45-degree field of view — 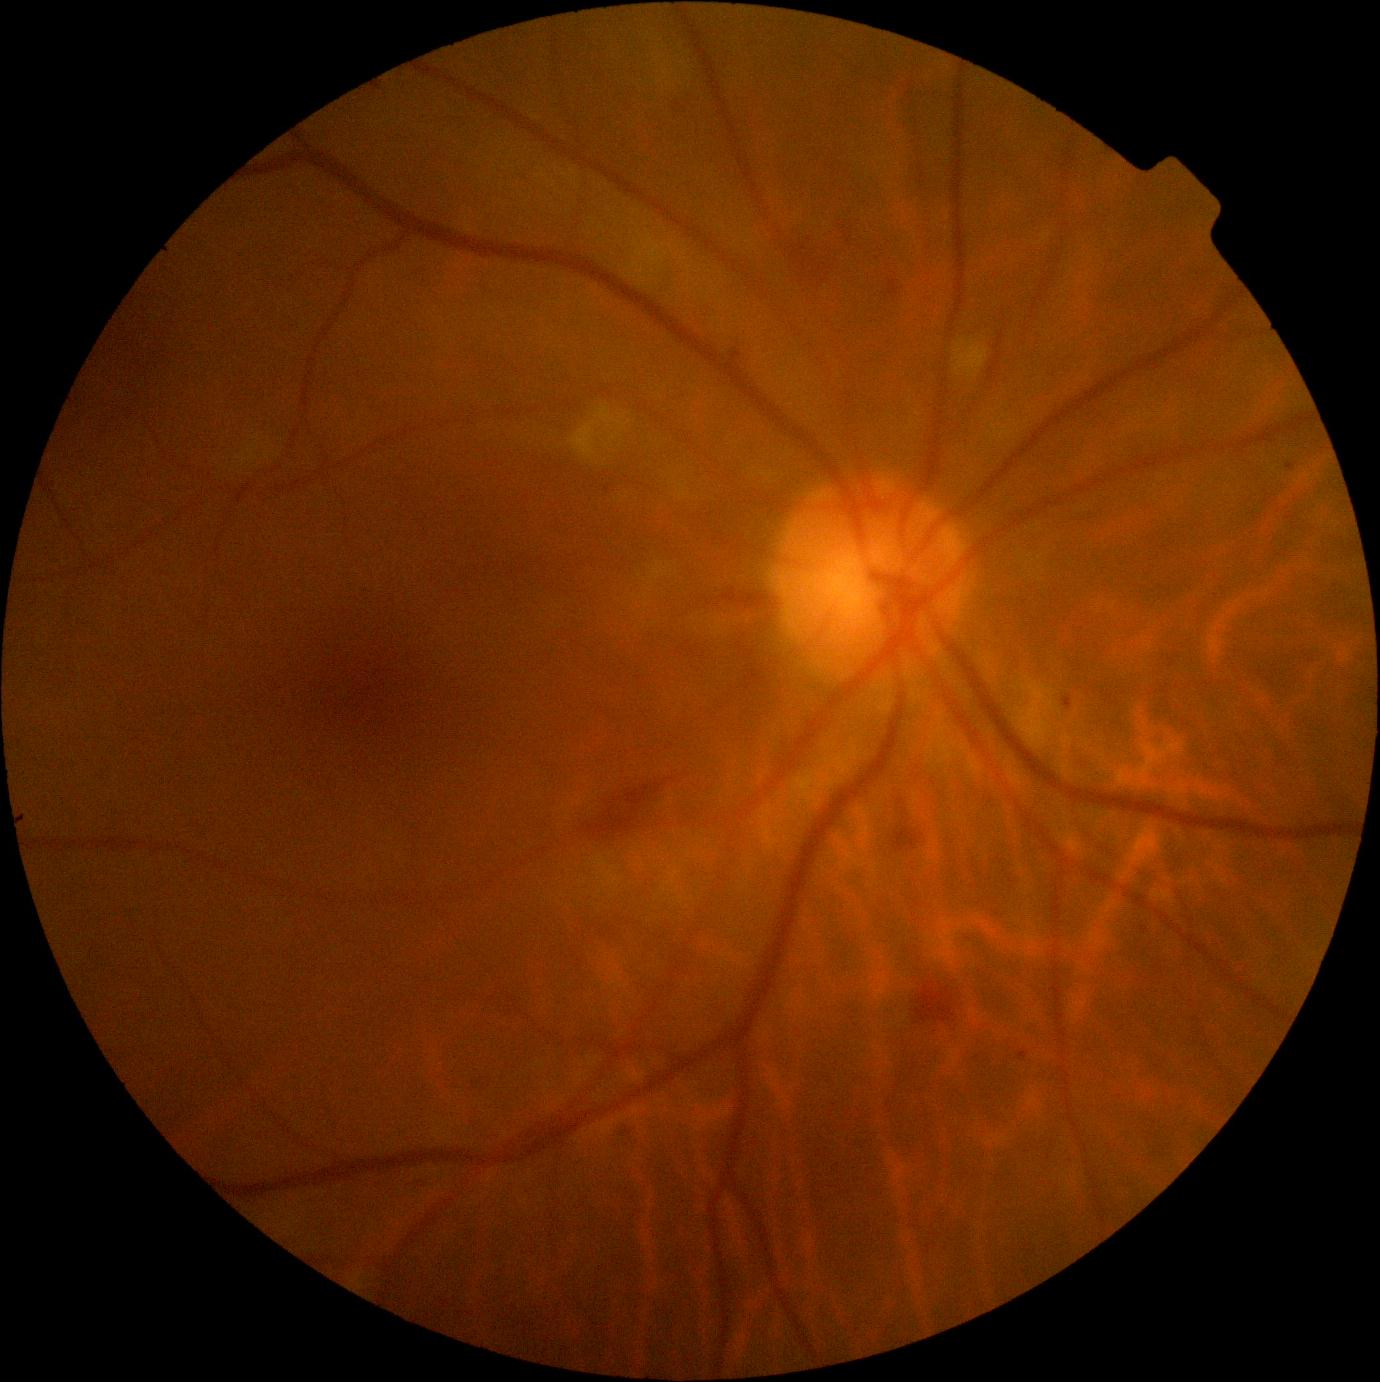
  dr_grade: moderate NPDR (grade 2)